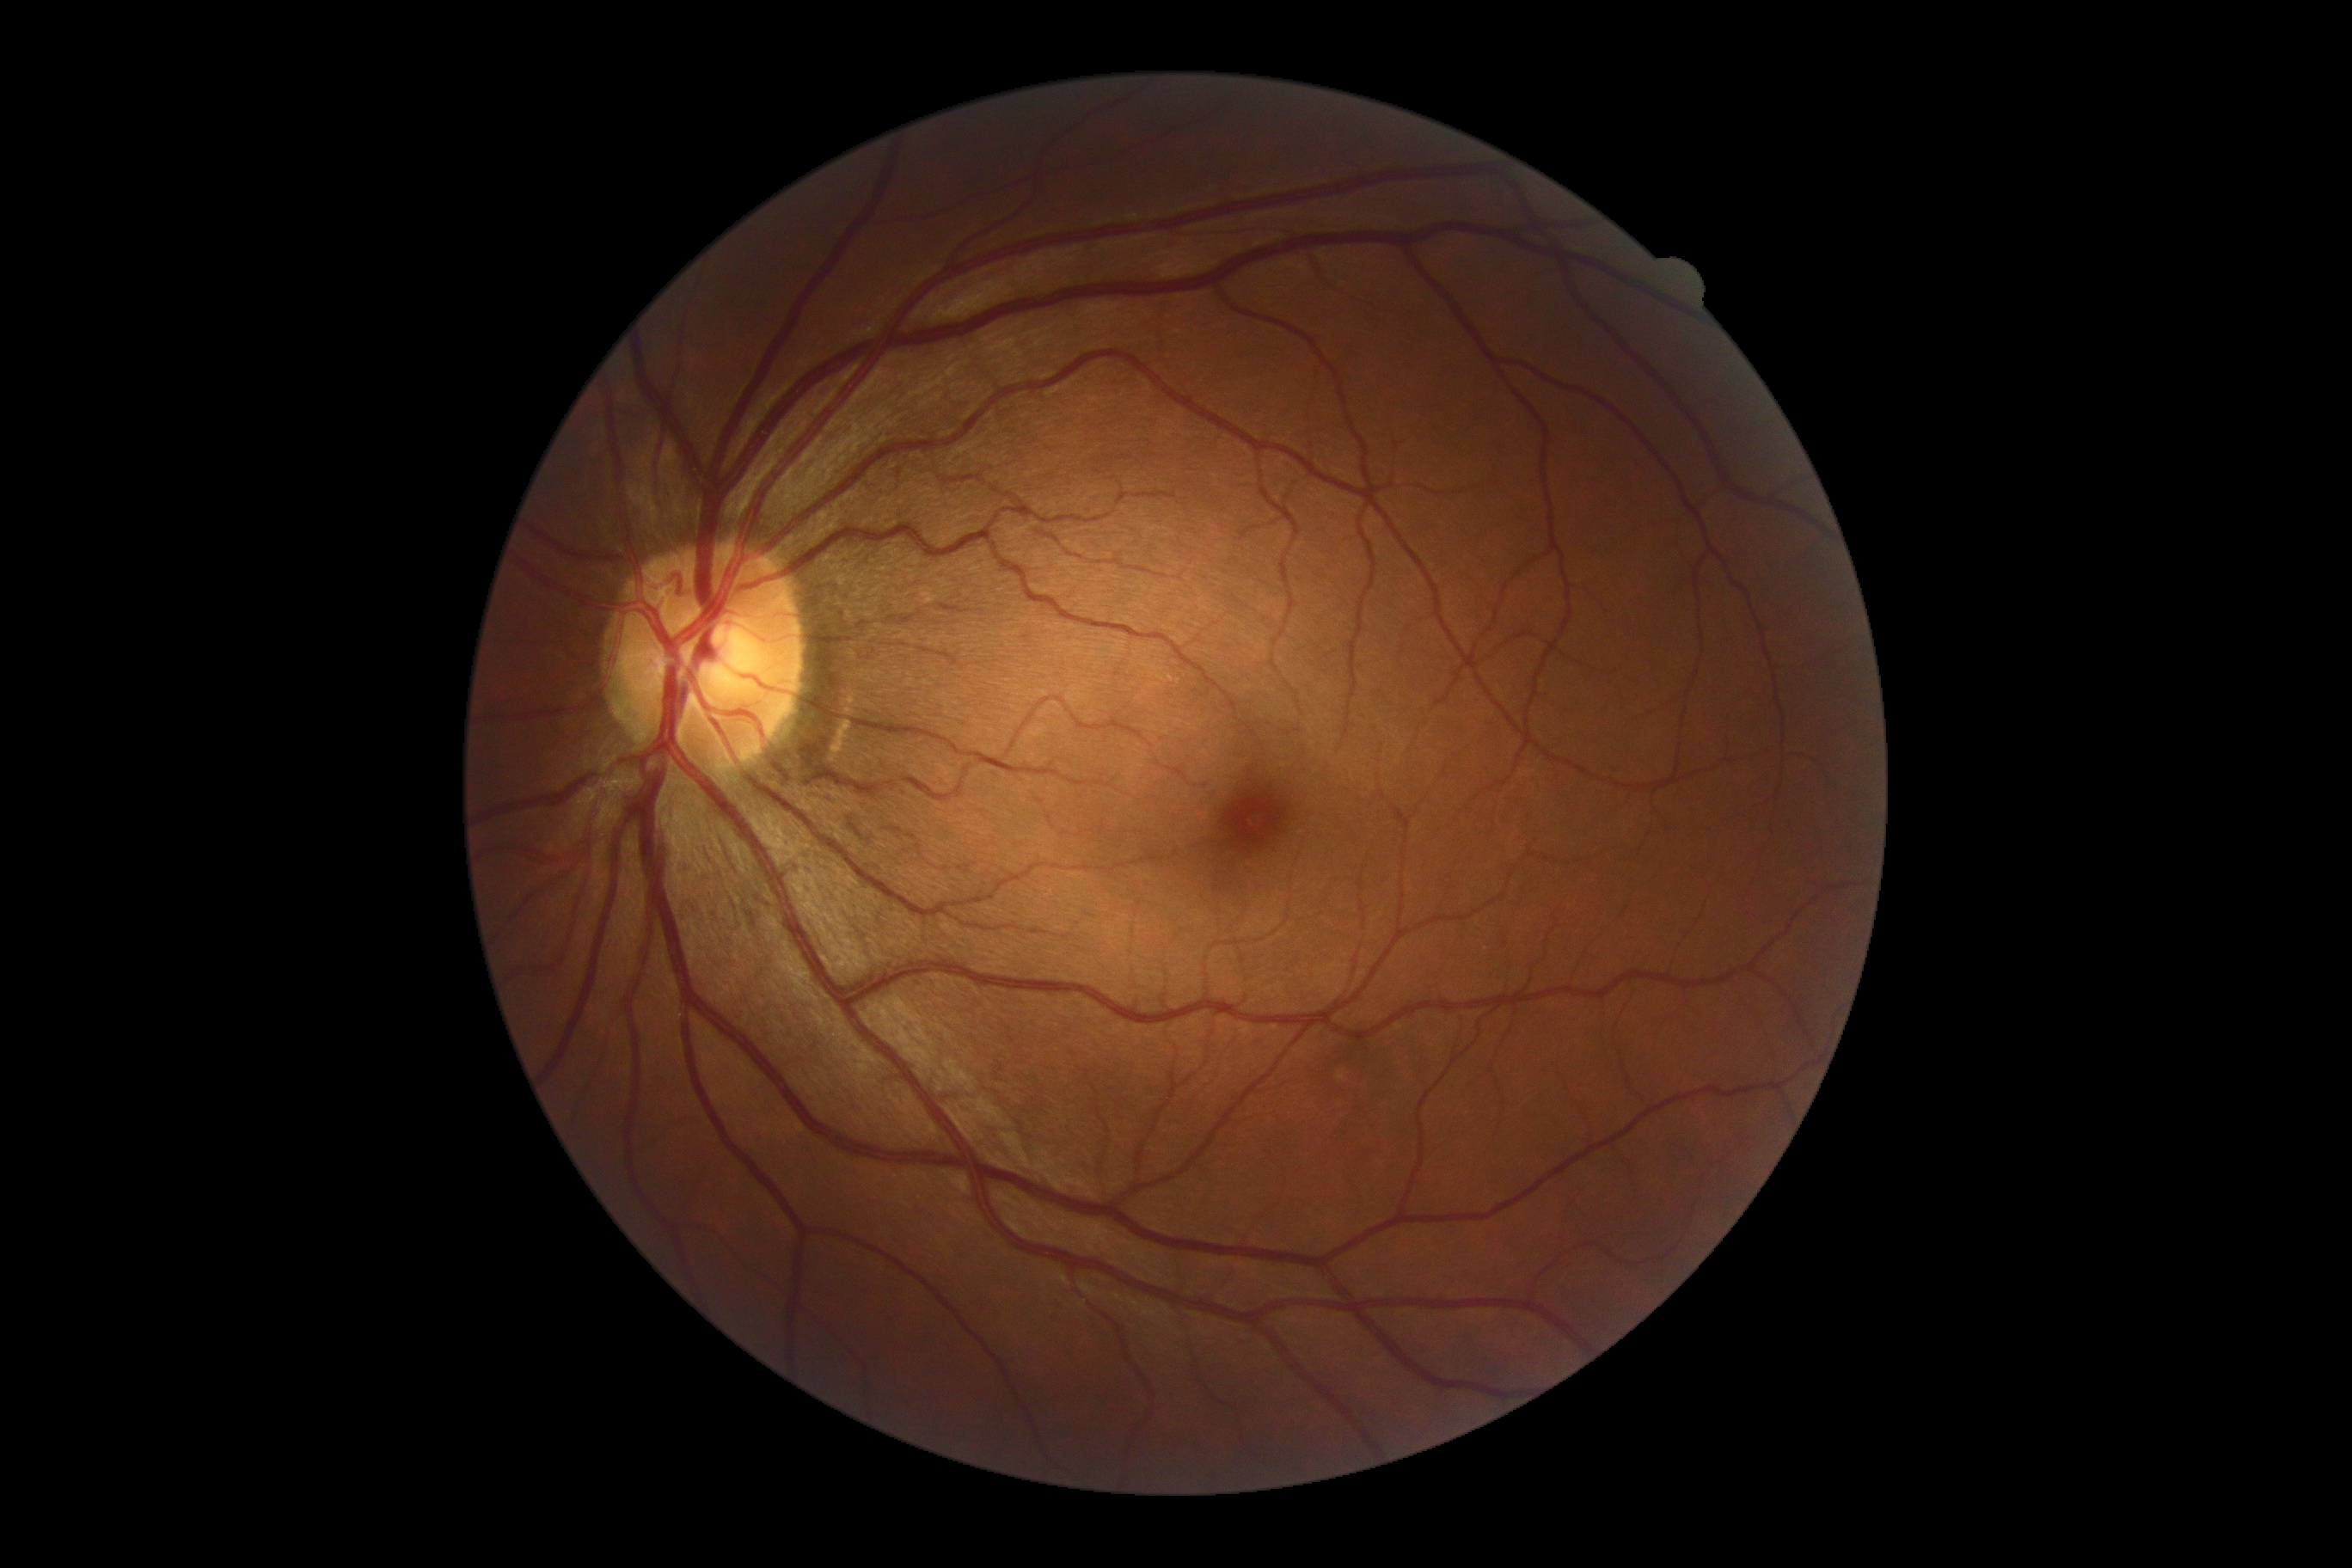
Diabetic retinopathy (DR) is no apparent diabetic retinopathy (grade 0).
No apparent diabetic retinopathy.